2048 by 1536 pixels. Color fundus image. 45° FOV
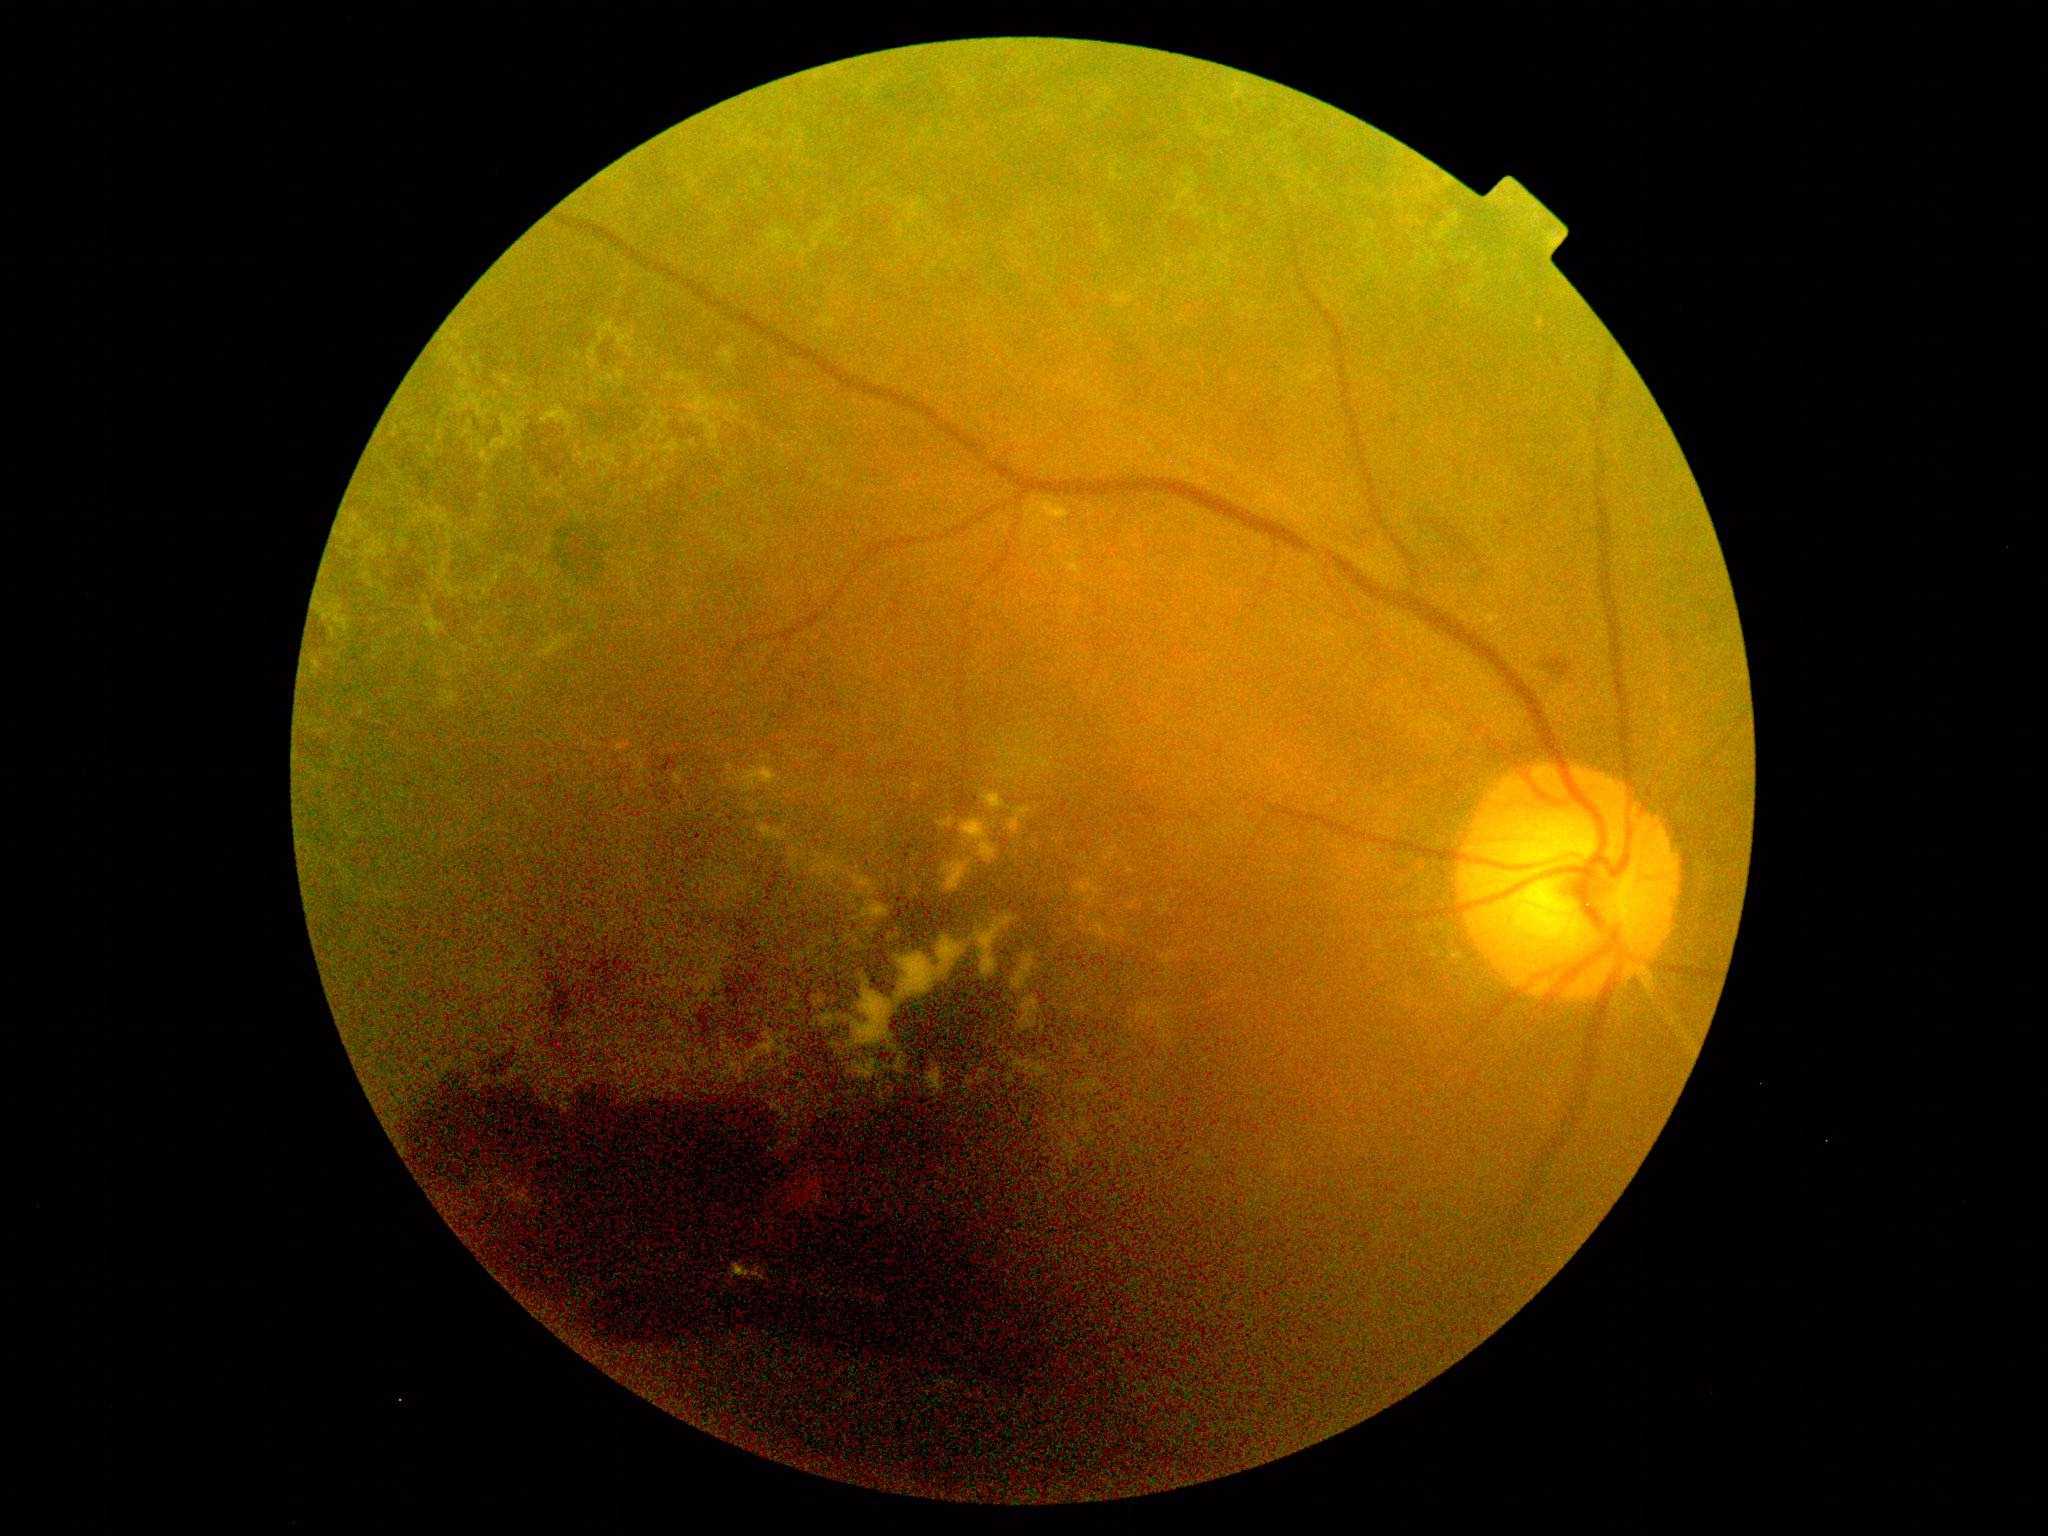 Diabetic retinopathy grade: 4 (PDR).